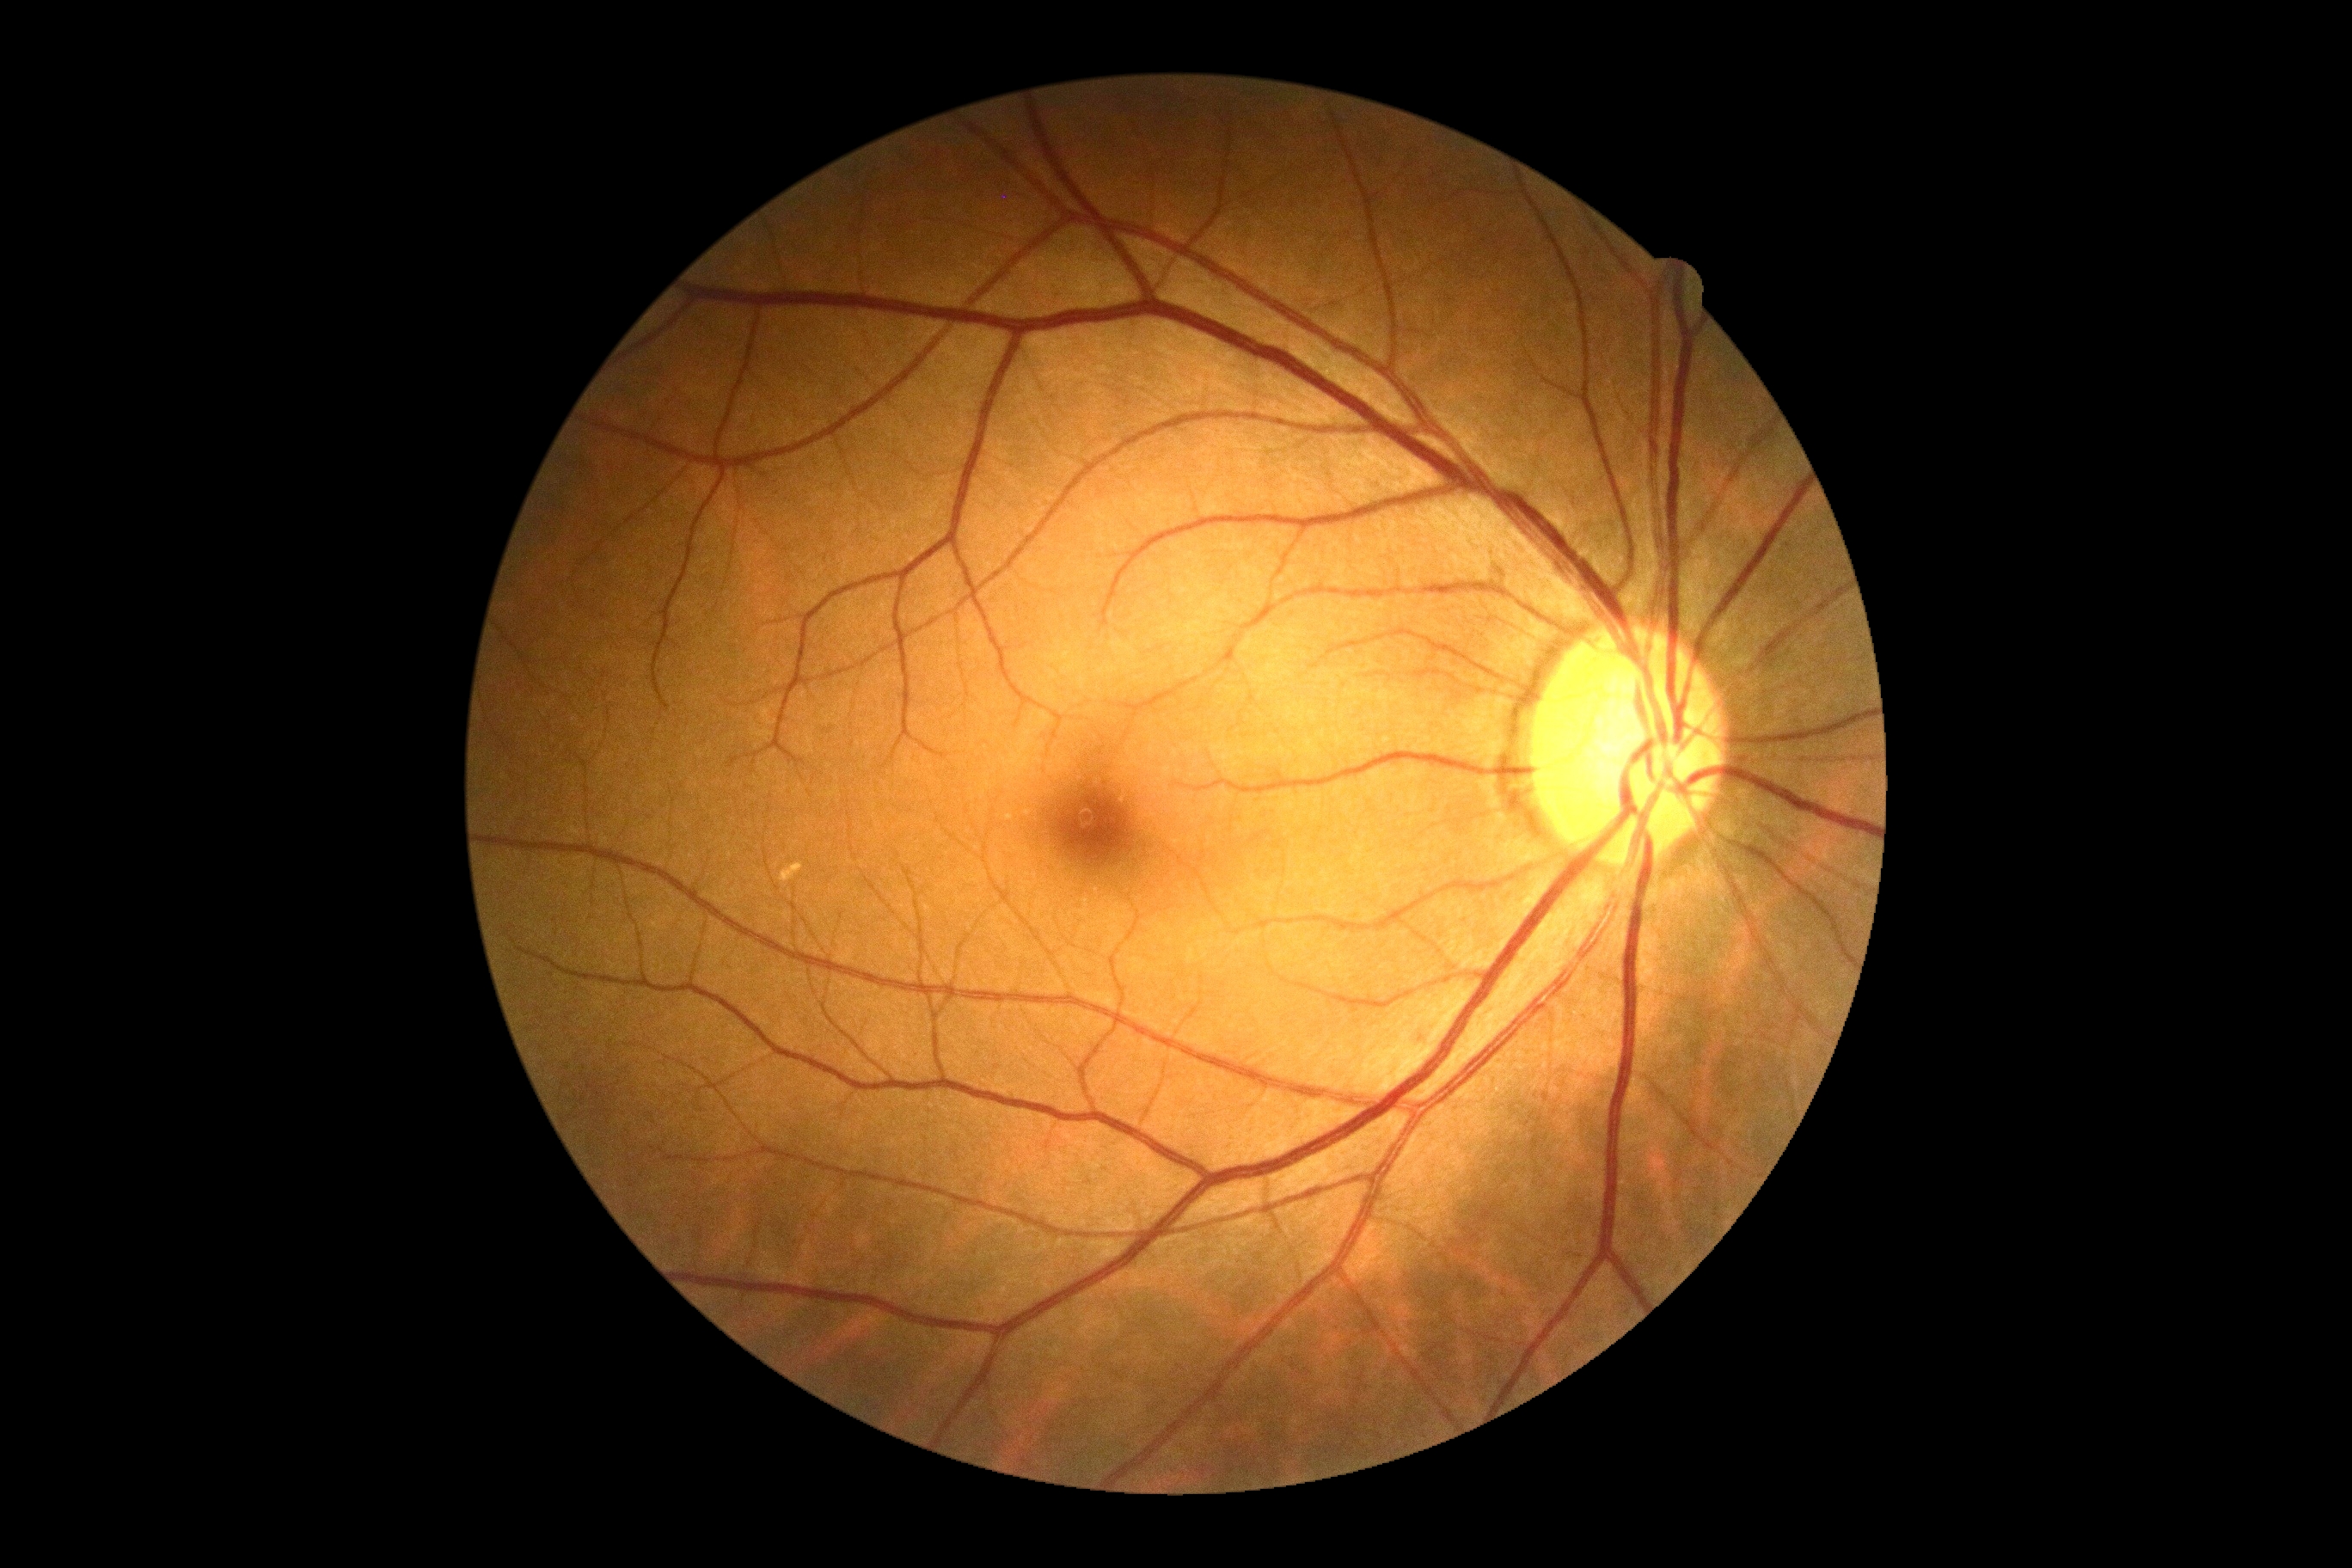
diabetic retinopathy severity = grade 0; DR impression = negative for DR.